Fundus photo; 2352 x 1568 pixels.
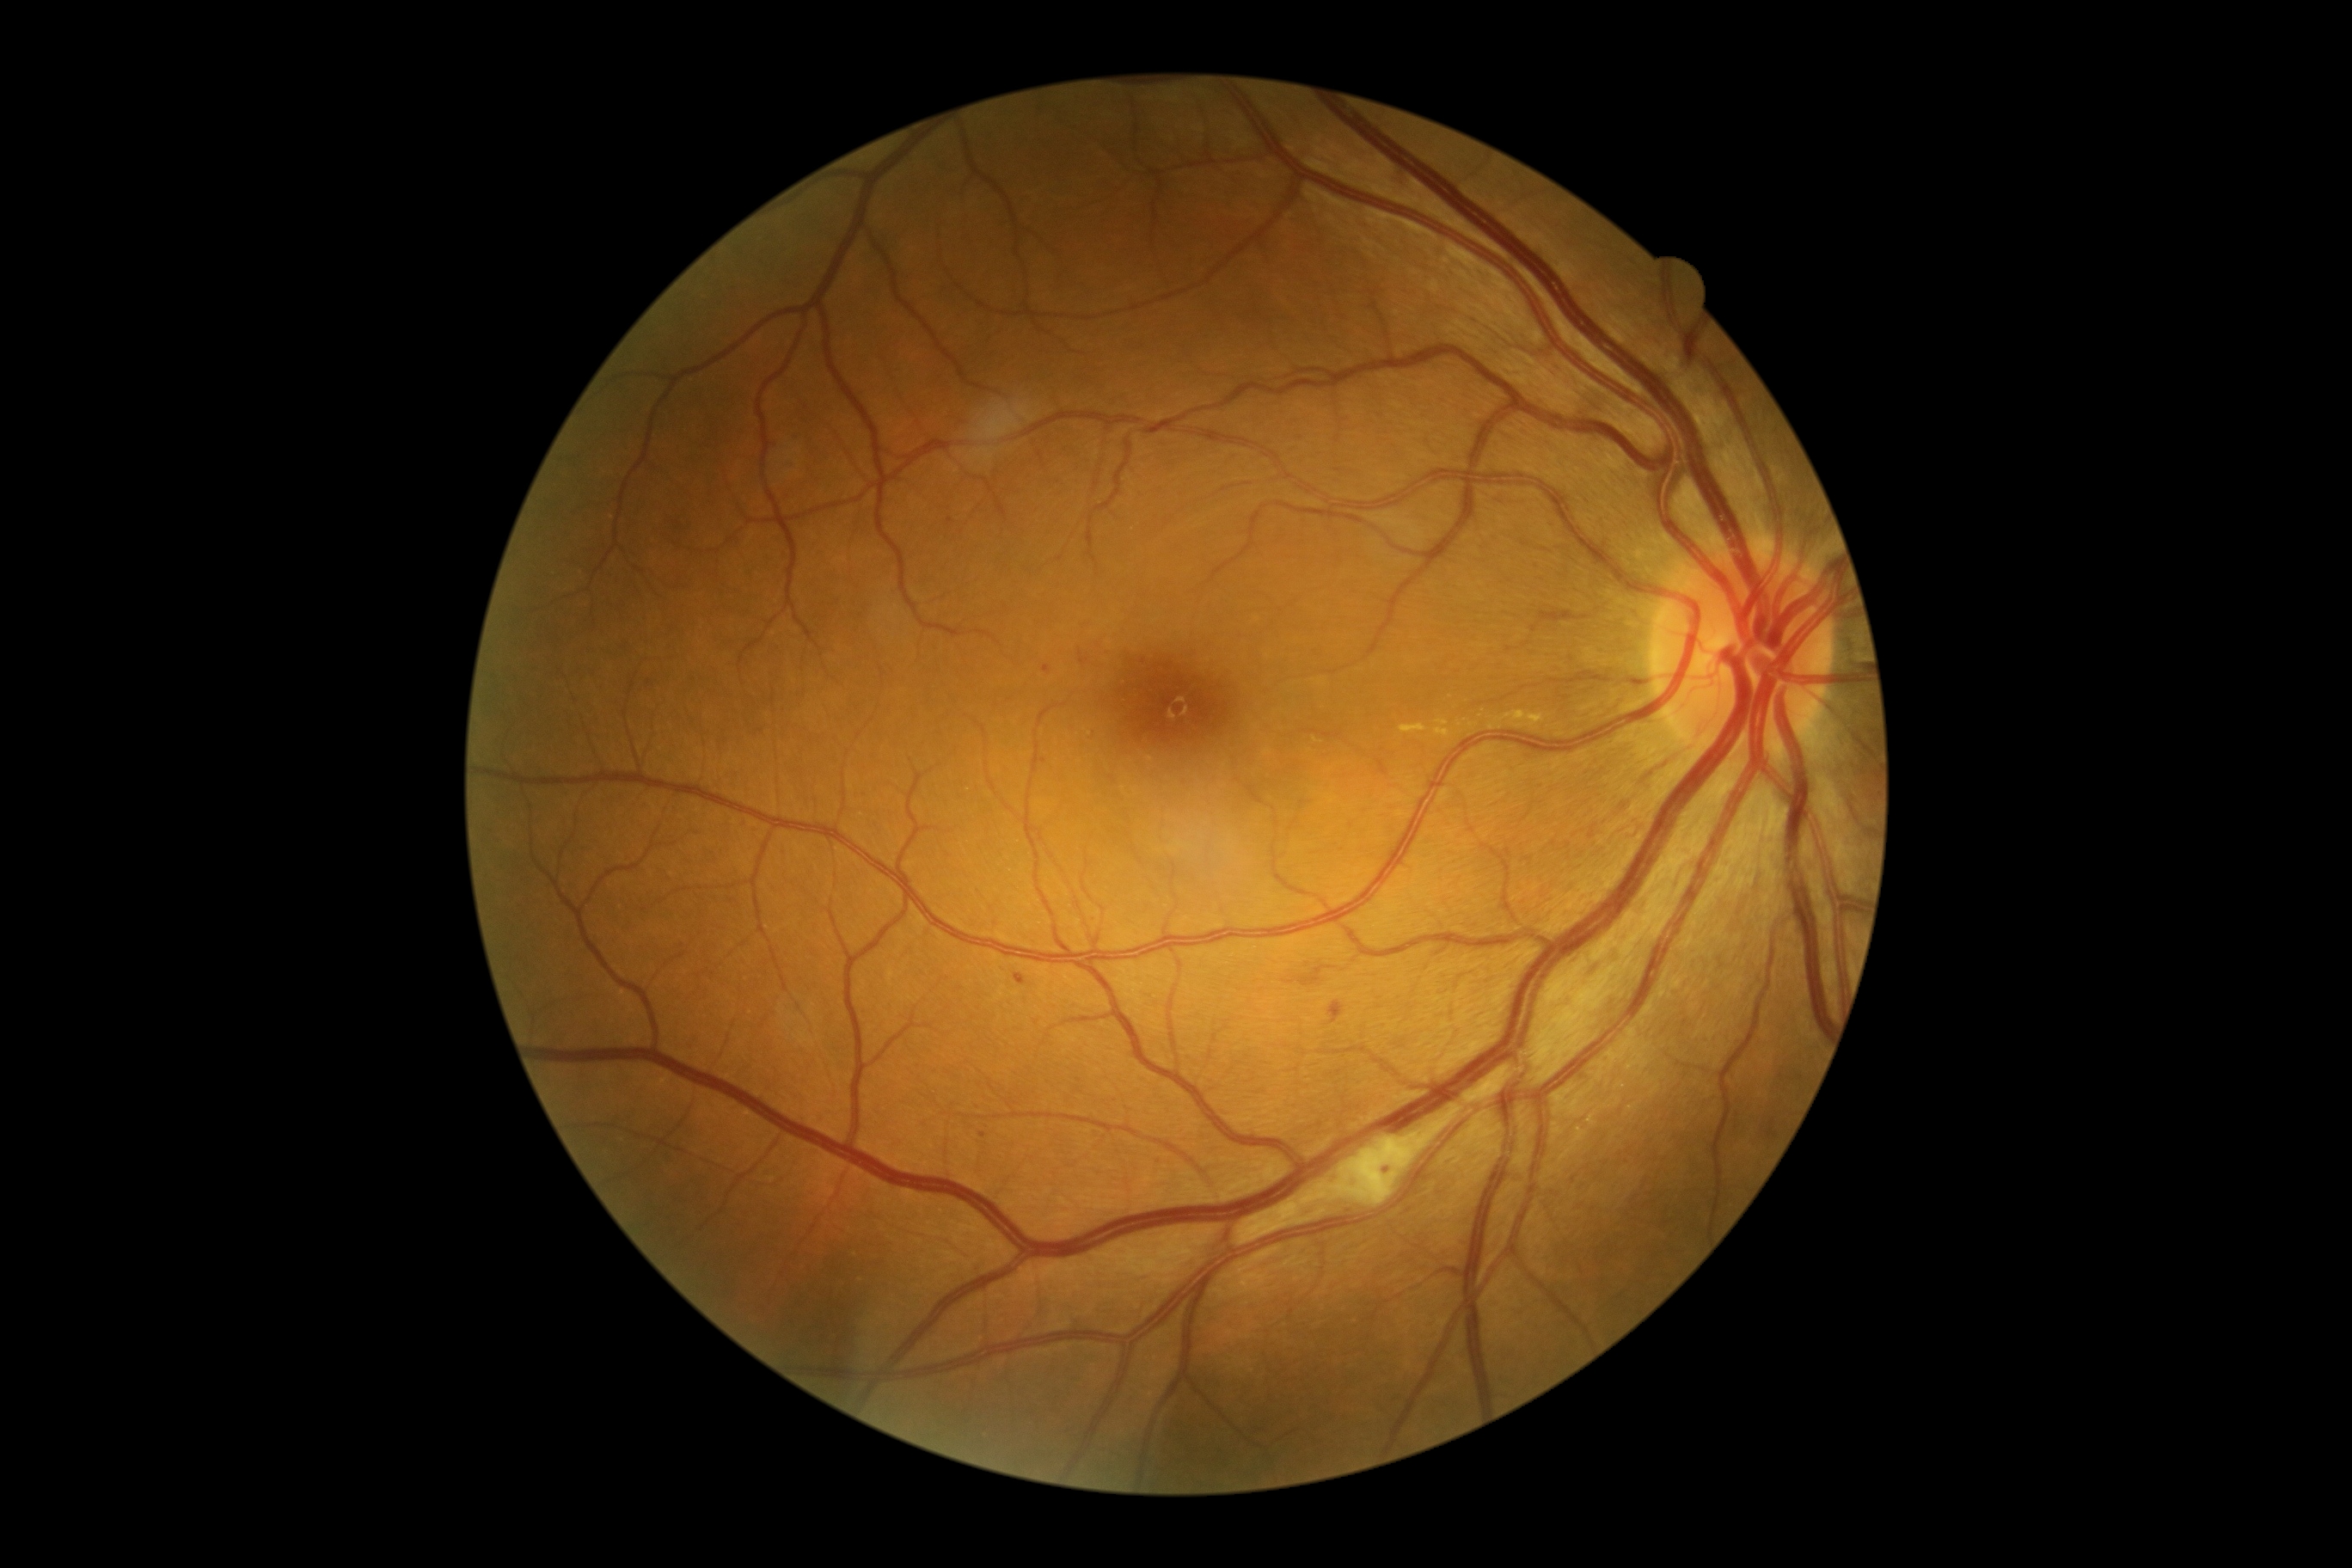
{"dr_category": "non-proliferative diabetic retinopathy", "dr_grade": "2"}